Pediatric wide-field fundus photograph; 640 x 480 pixels
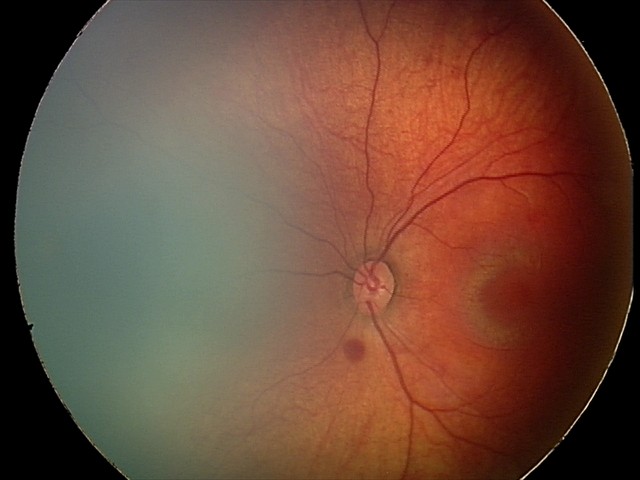

Screening diagnosis: retinal hemorrhages.